1932x1932px.
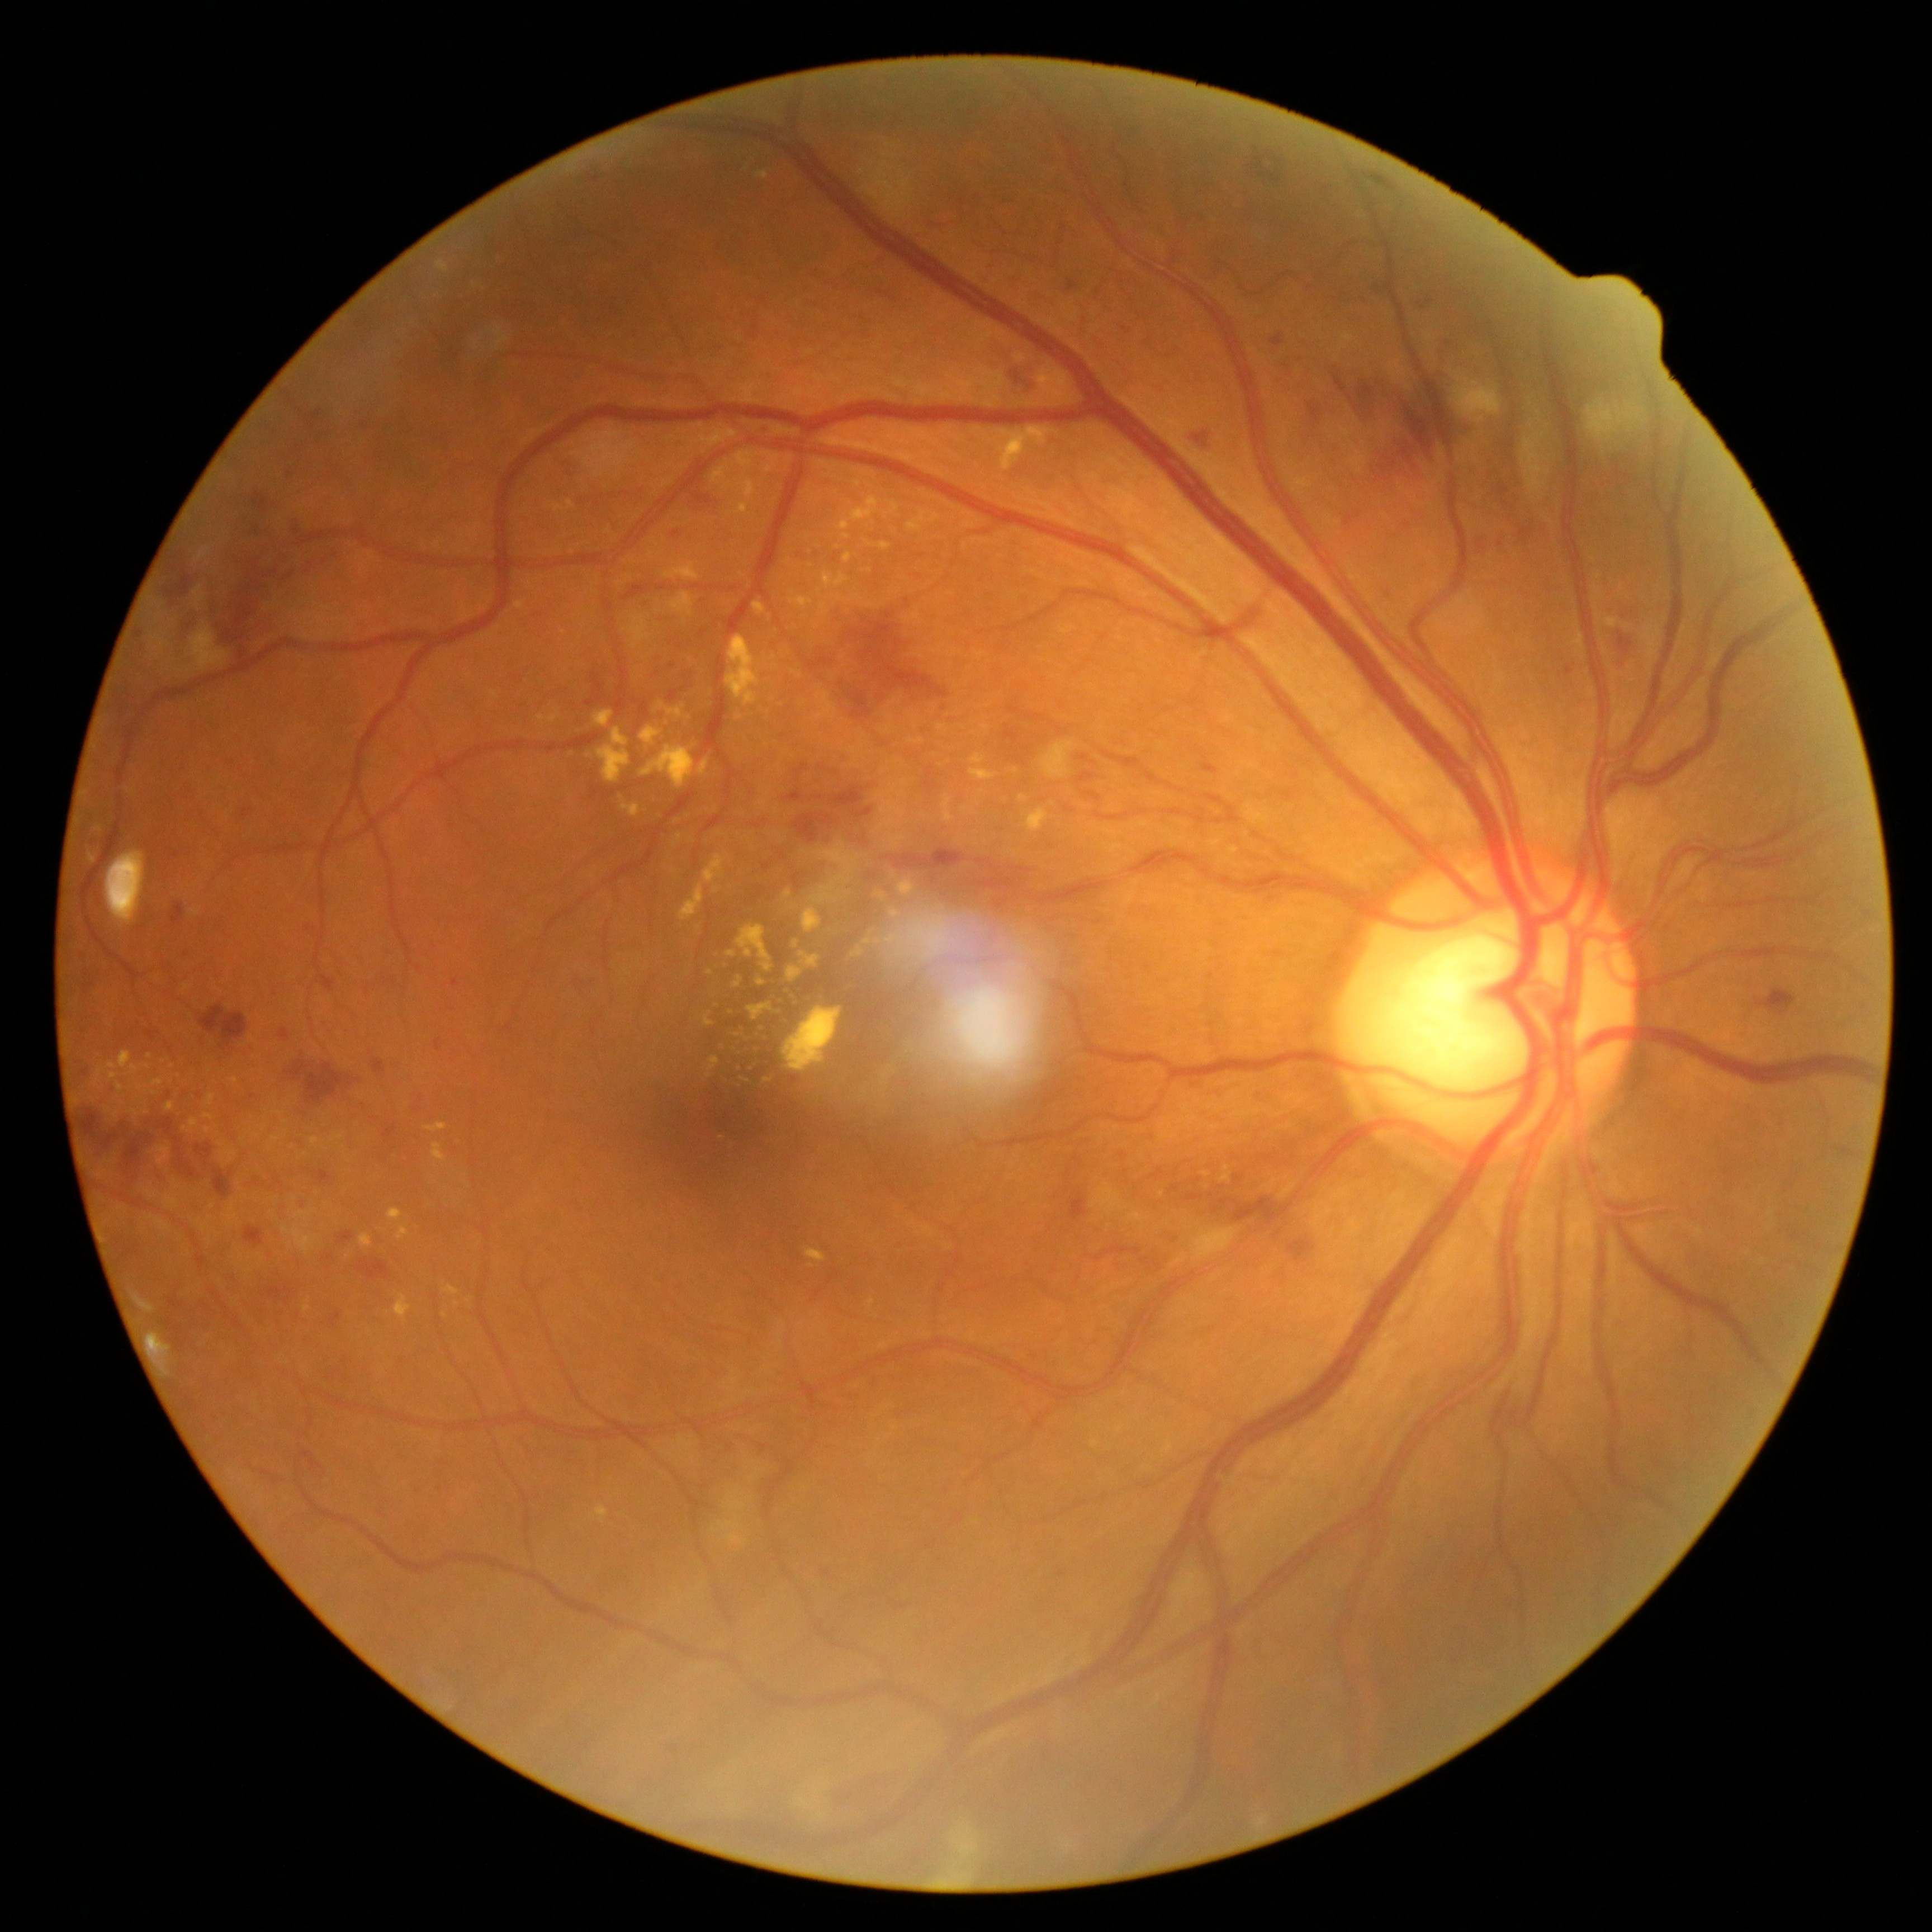

Retinopathy grade: 3 — more than 20 intraretinal hemorrhages in each of 4 quadrants, definite venous beading in 2 or more quadrants, or prominent intraretinal microvascular abnormalities in 1 or more quadrants, with no signs of proliferative retinopathy
Representative lesions:
hard exudates (continued): 799/952/820/970 | 885/500/899/518 | 757/980/766/988 | 397/1228/409/1242 | 755/172/770/181 | 640/727/664/752 | 293/1213/311/1223 | 190/1119/198/1130 | 110/1074/119/1083 | 598/728/631/784
Small hard exudates near (884,899) | (797,1005) | (768,1081) | (208,1131) | (457,1305) | (967,809) | (838,548)